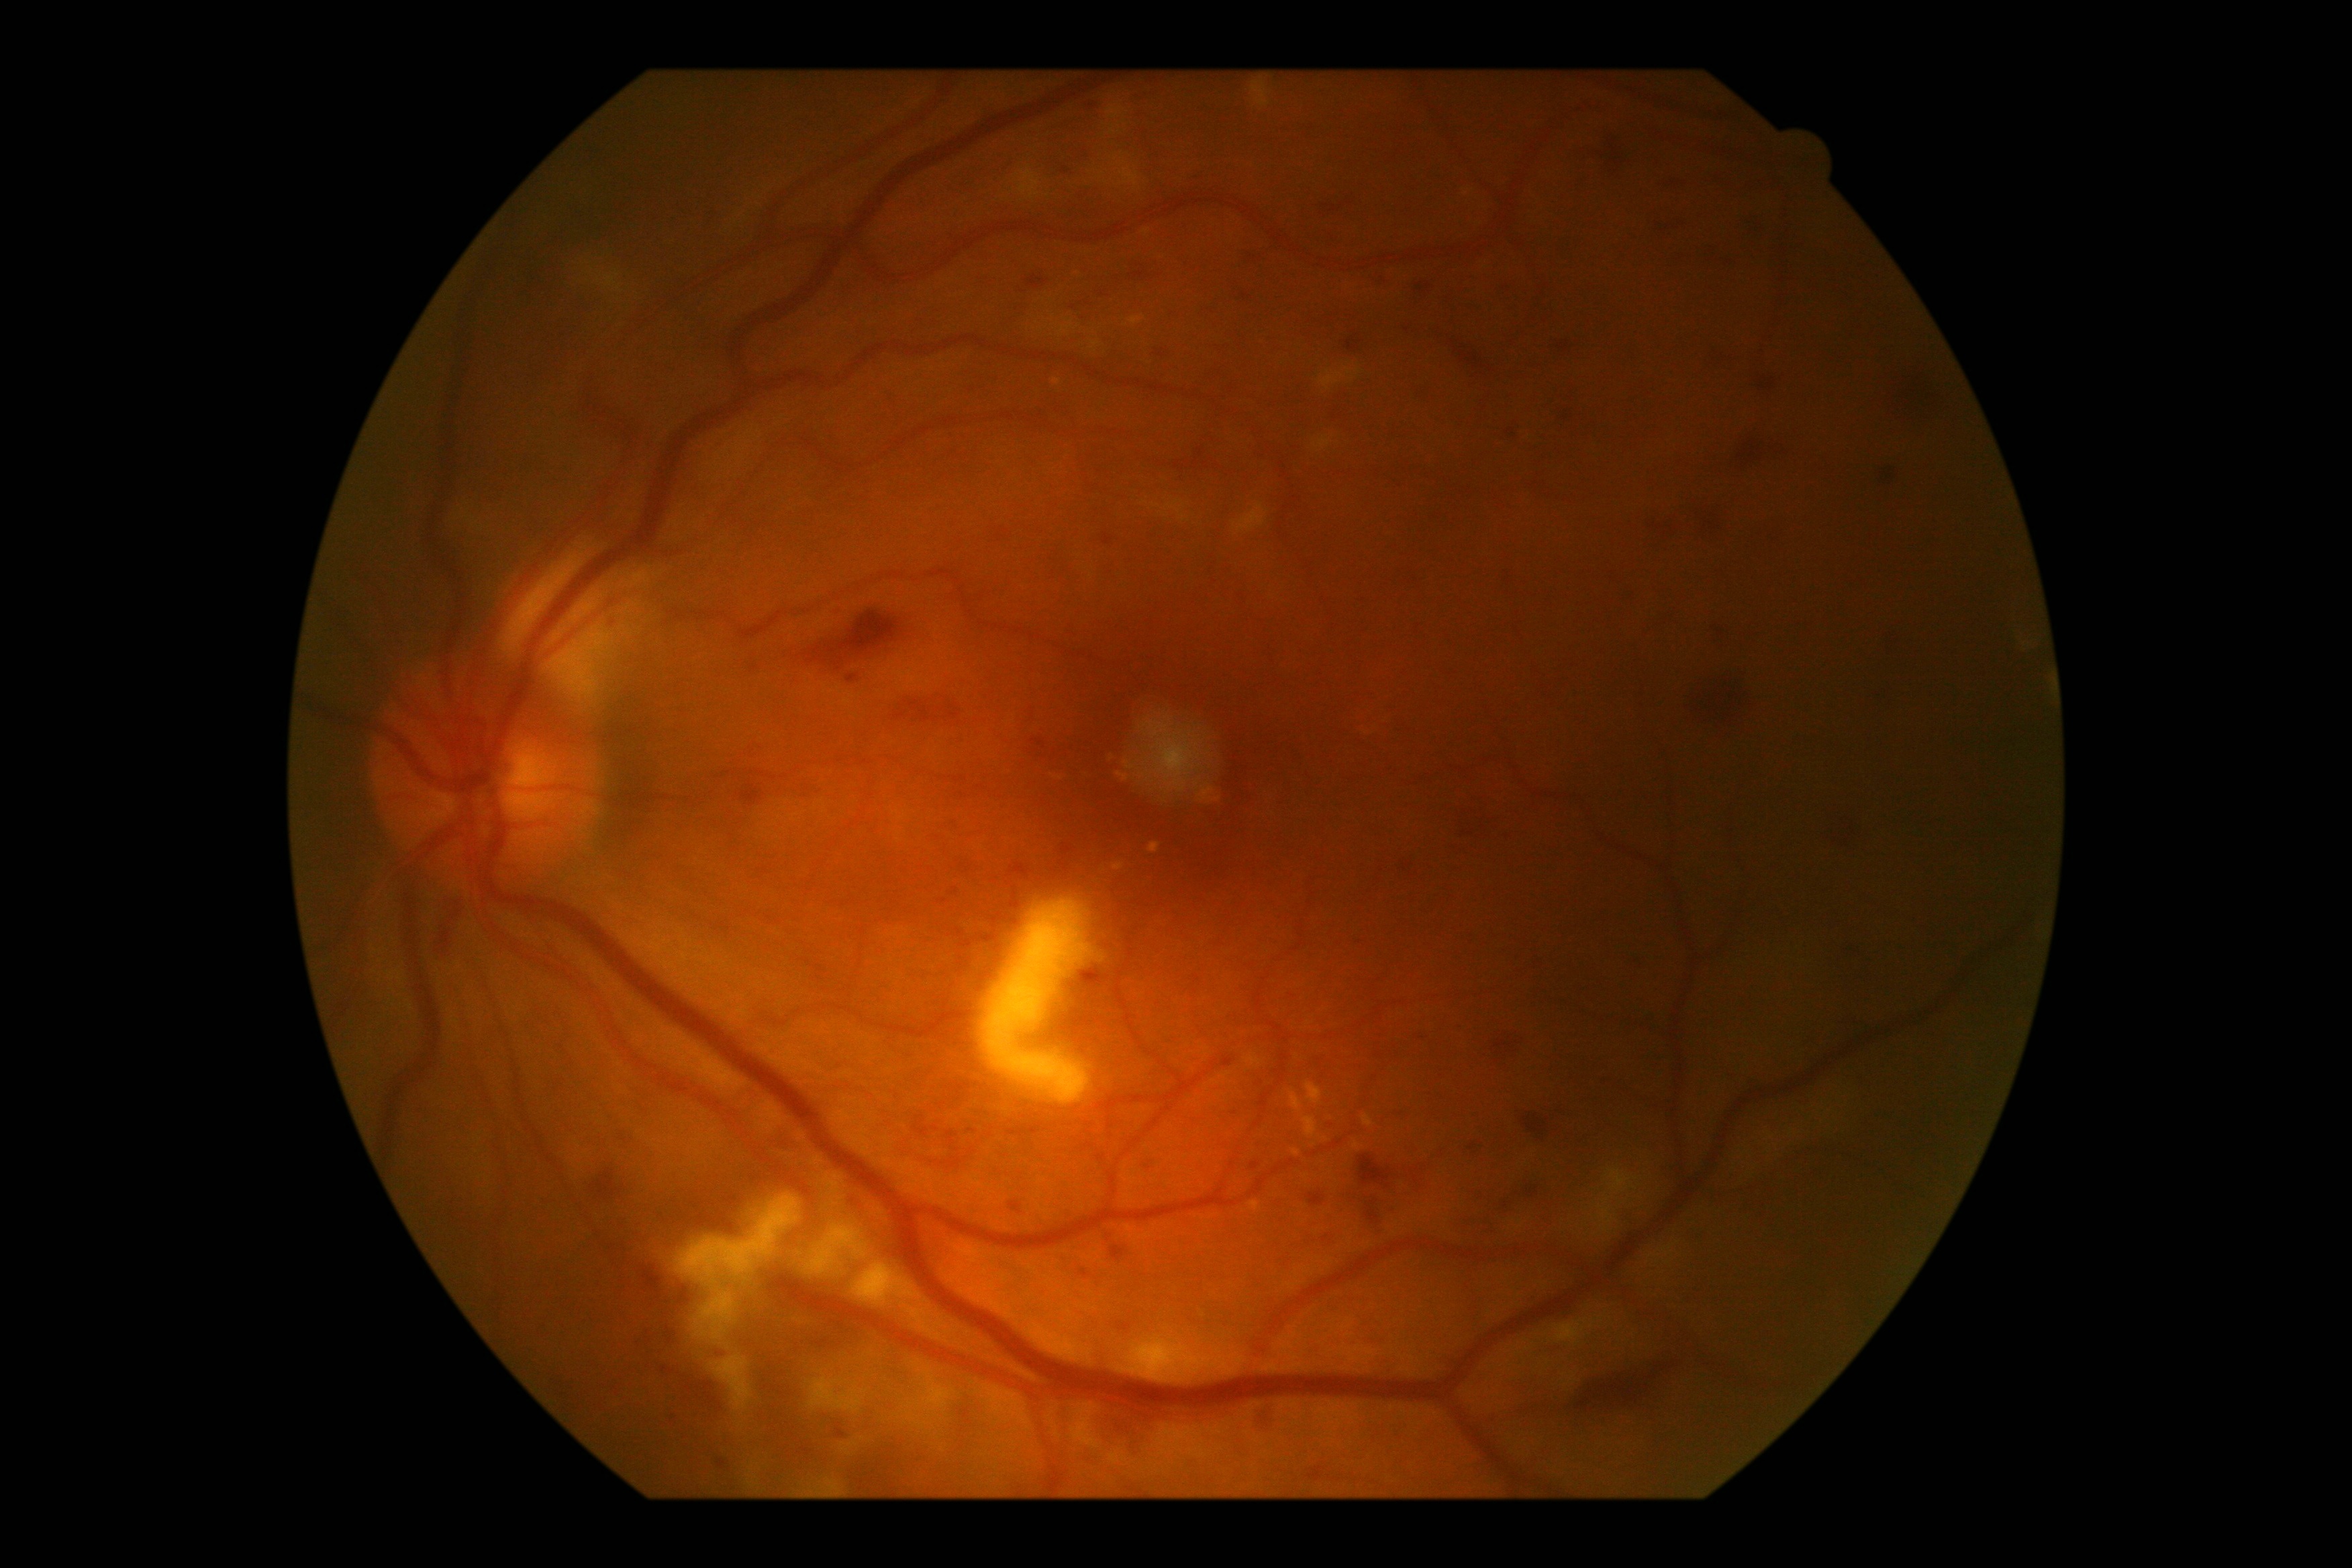 Diabetic retinopathy (DR) is grade 2.
The retinopathy is classified as non-proliferative diabetic retinopathy.